Image size 640x480. Wide-field fundus photograph from neonatal ROP screening.
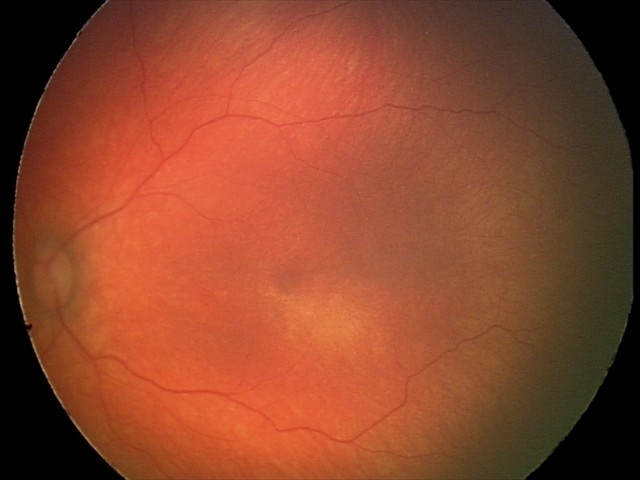 Q: What is the diagnosis from this examination?
A: normal fundus examination